45° FOV:
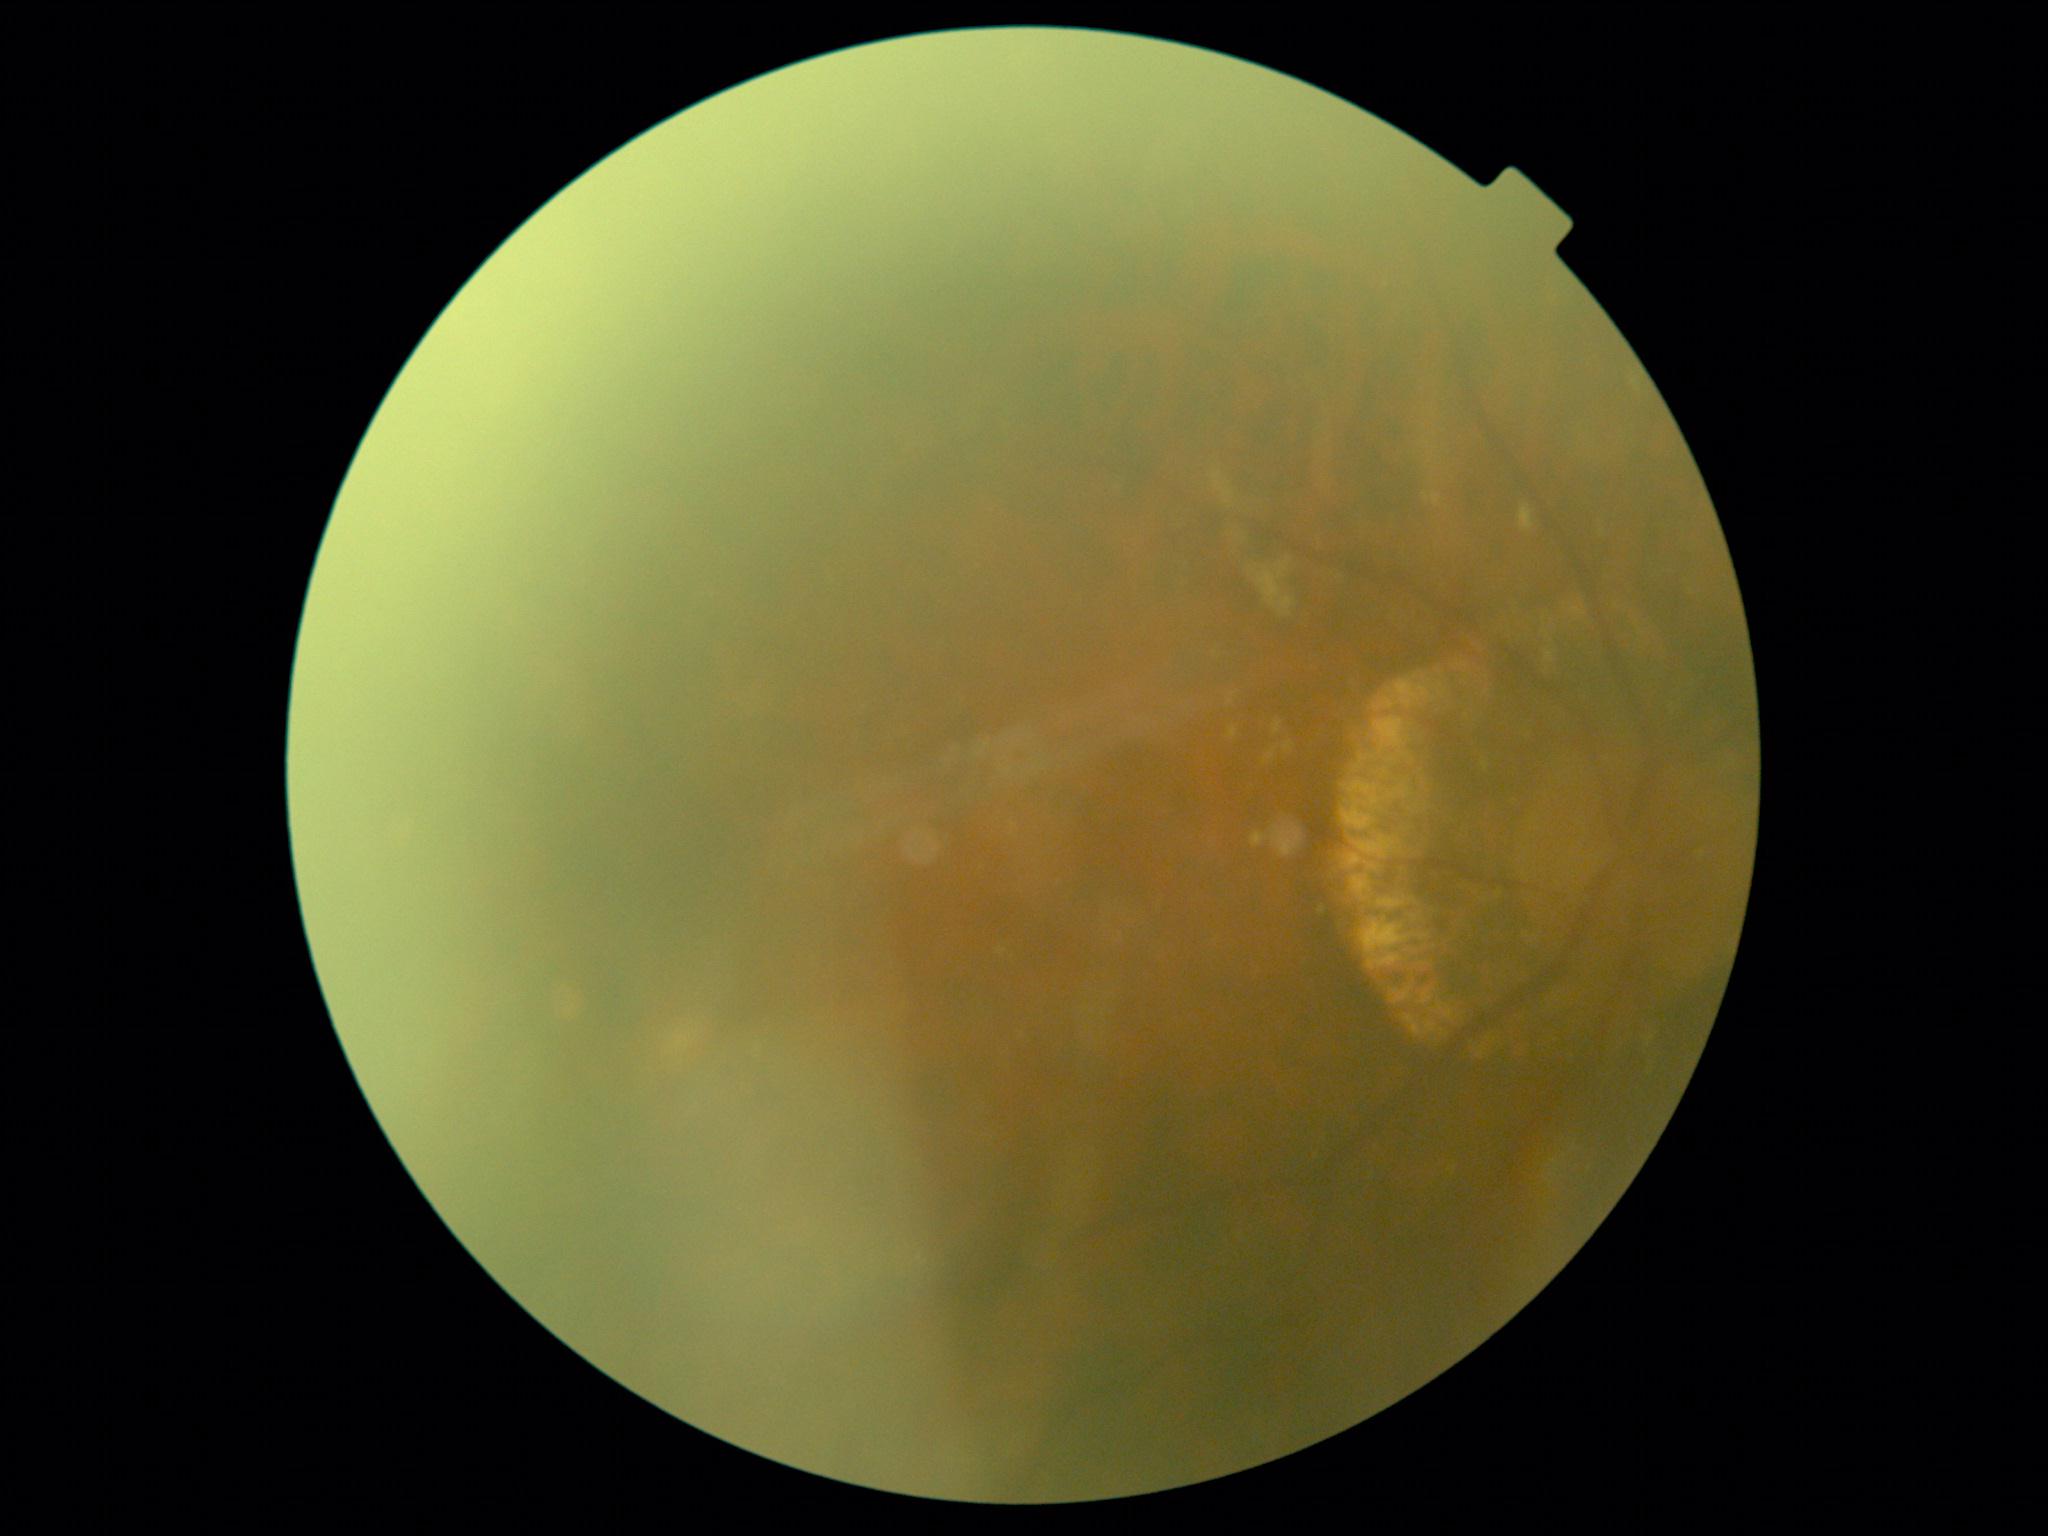

image quality = too poor for DR grading | diabetic retinopathy (DR) = ungradable.